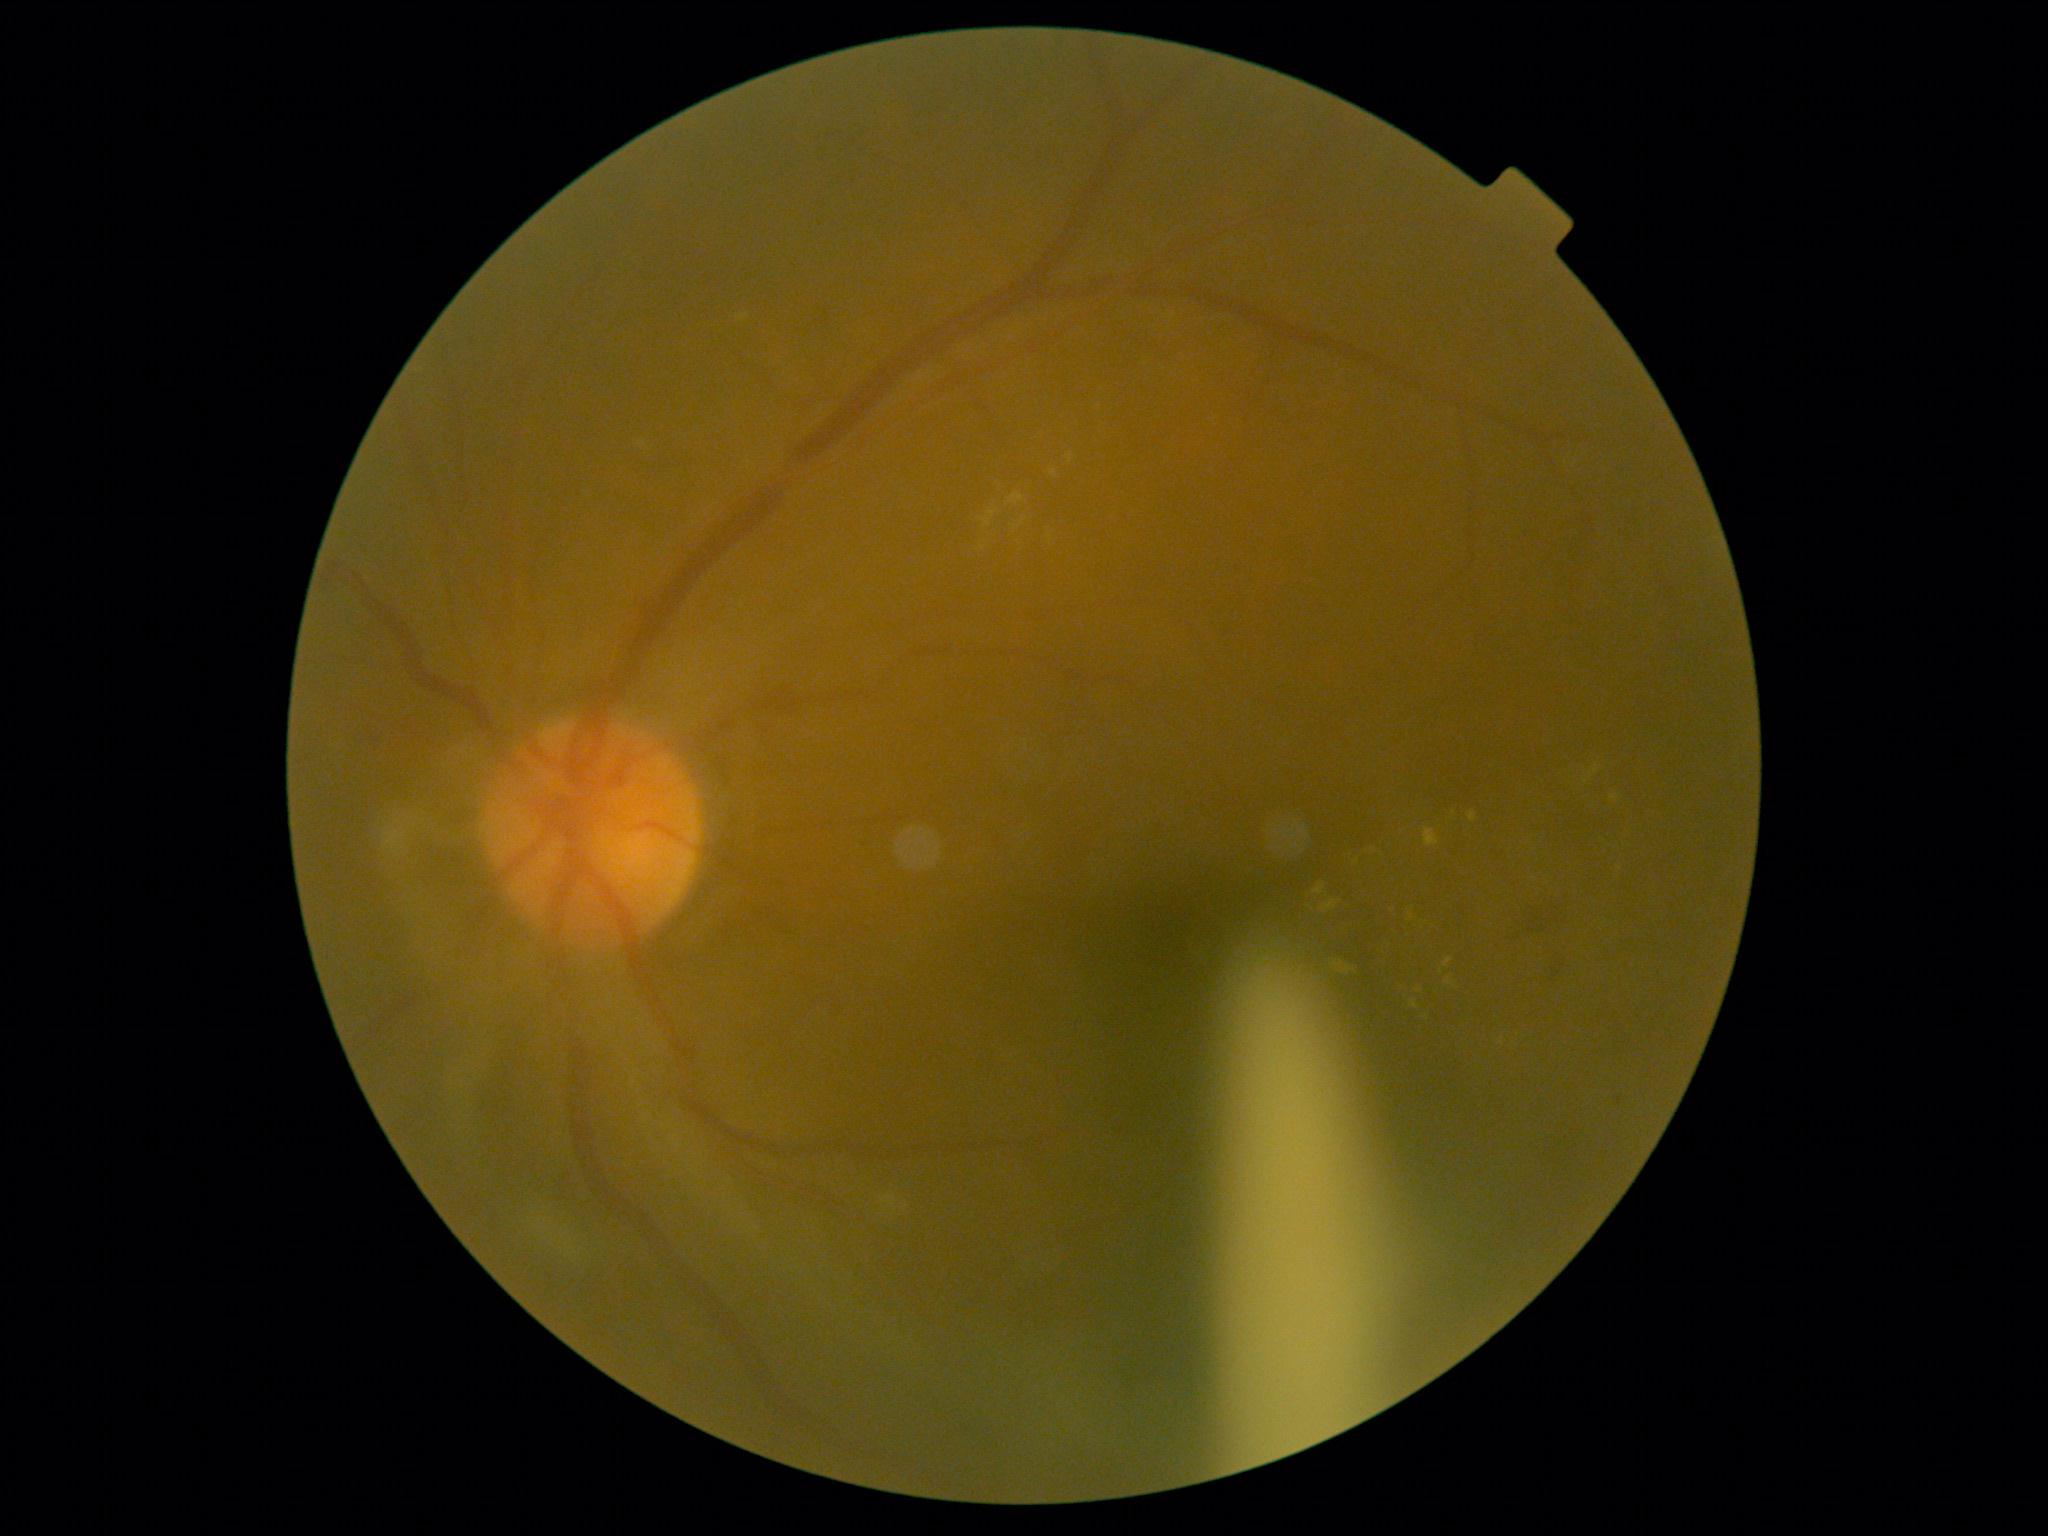

Findings:
- DR stage — grade 2 (moderate NPDR)